848x848px, diabetic retinopathy graded by the modified Davis classification: 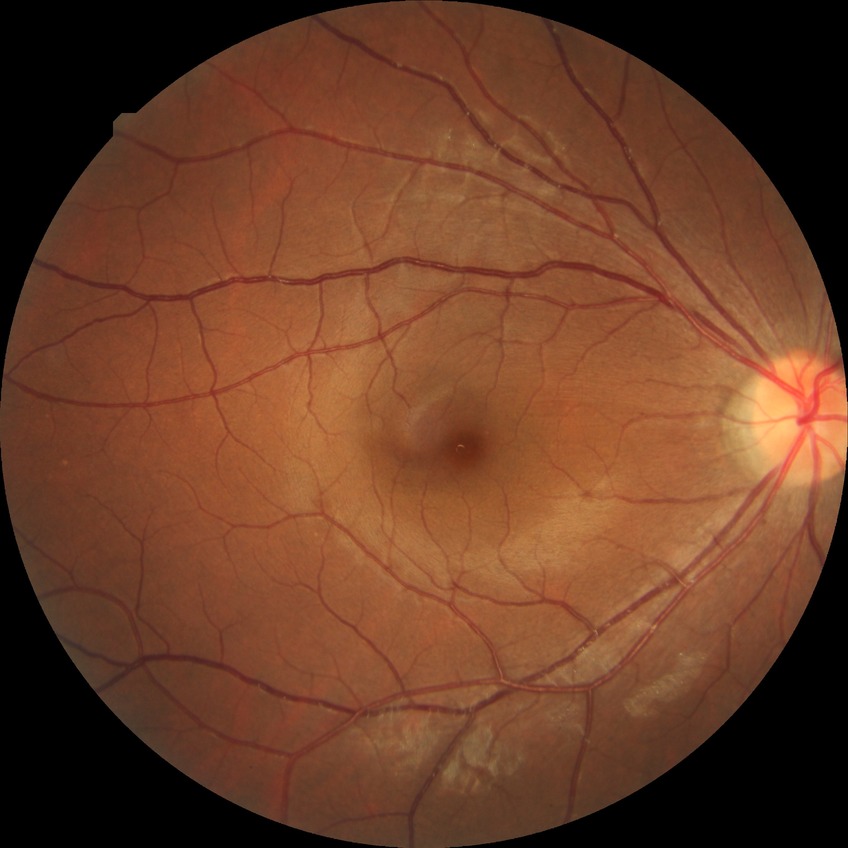
diabetic retinopathy (DR) = no diabetic retinopathy (NDR).